45° FOV; 1380 by 1382 pixels
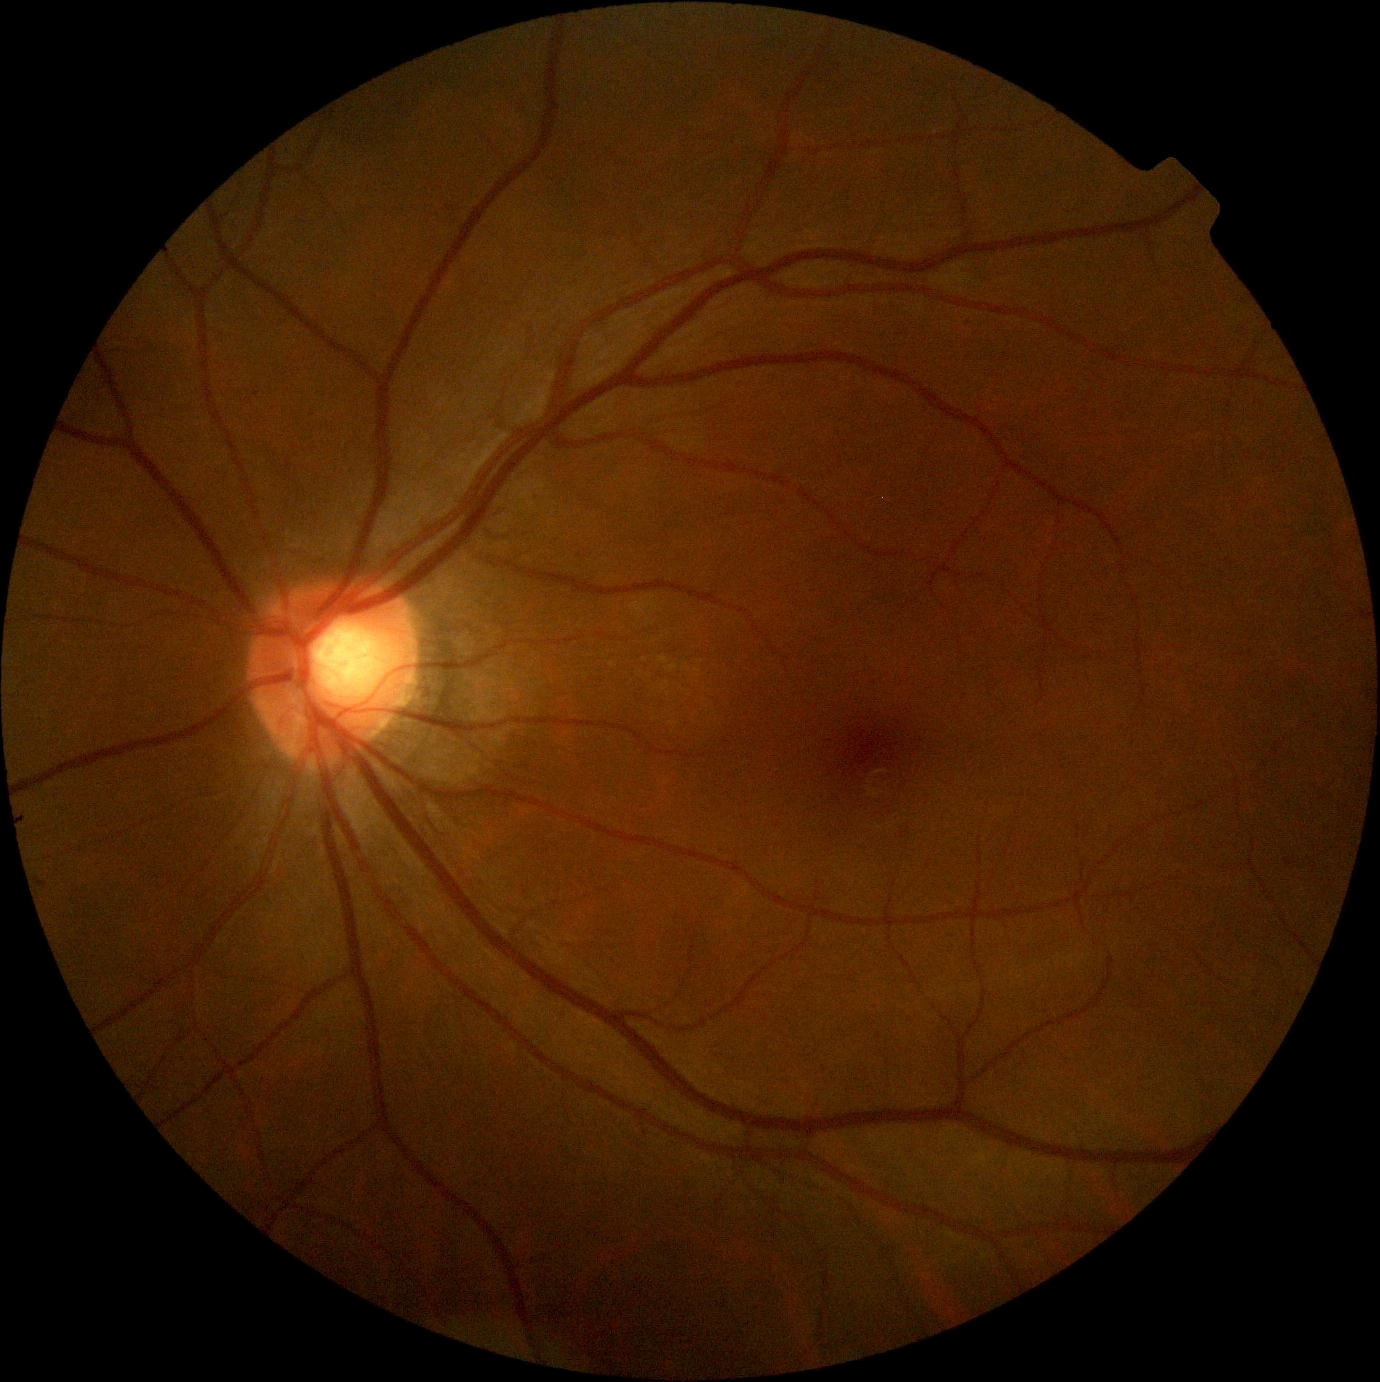

DR is 0/4 — no visible signs of diabetic retinopathy.